Nidek AFC-330. Optic disc-centered crop: 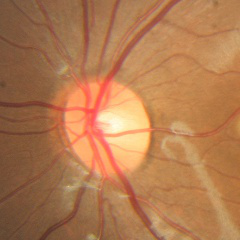 The image shows no evidence of glaucoma.